Optic disc region crop · captured without pupil dilation — 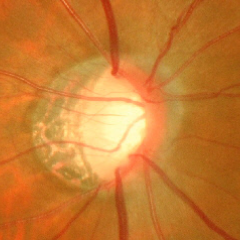 Glaucomatous changes are present.
Advanced glaucomatous optic neuropathy.